Acquired on the Clarity RetCam 3. RetCam wide-field infant fundus image
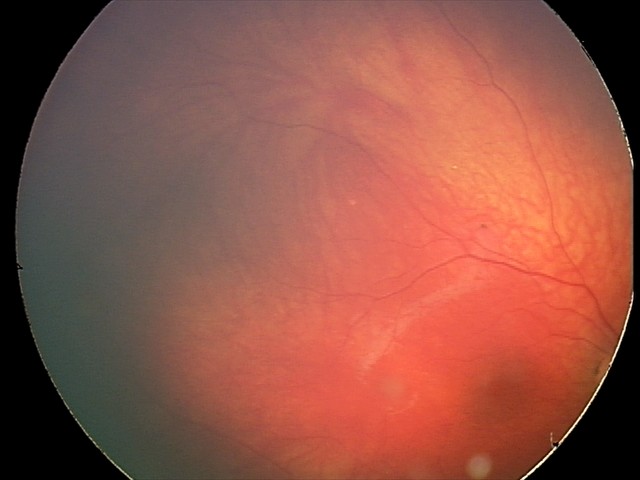

Diagnosis from this screening exam: retinal astrocytic hamartoma.